Diabetic retinopathy graded by the modified Davis classification: 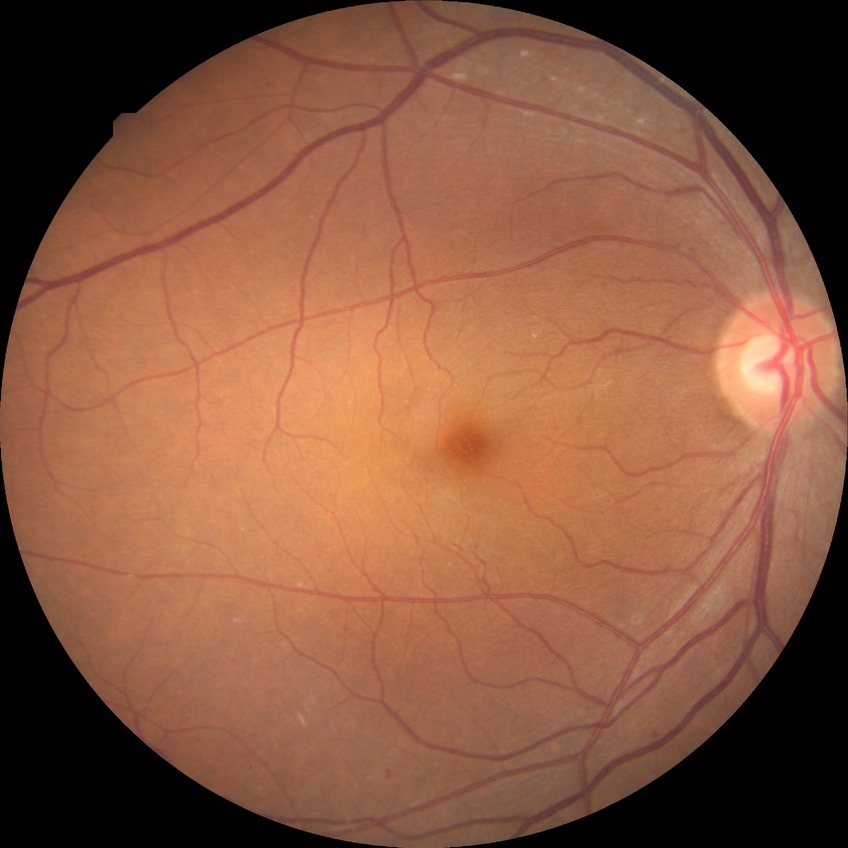

diabetic retinopathy (DR)@simple diabetic retinopathy (SDR).